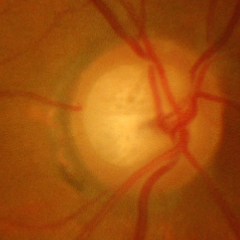

Assessment: advanced glaucoma.